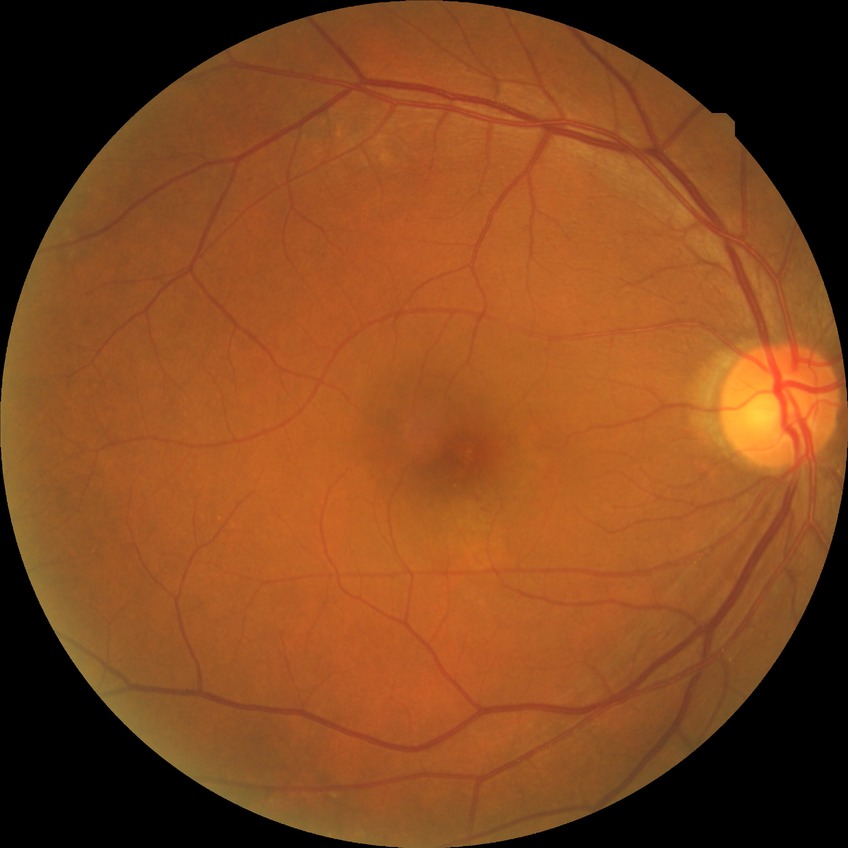 Modified Davis classification is no diabetic retinopathy.